Image size 640x480 · wide-field fundus photograph of an infant
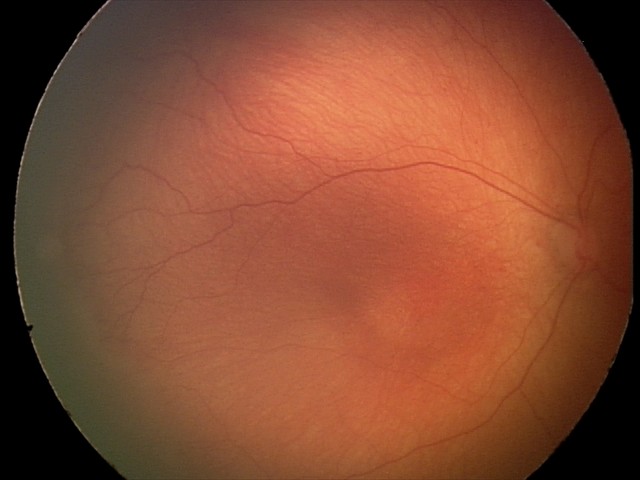
Impression: no plus disease | retinopathy of prematurity (ROP) stage 1.